DR severity per modified Davis staging — 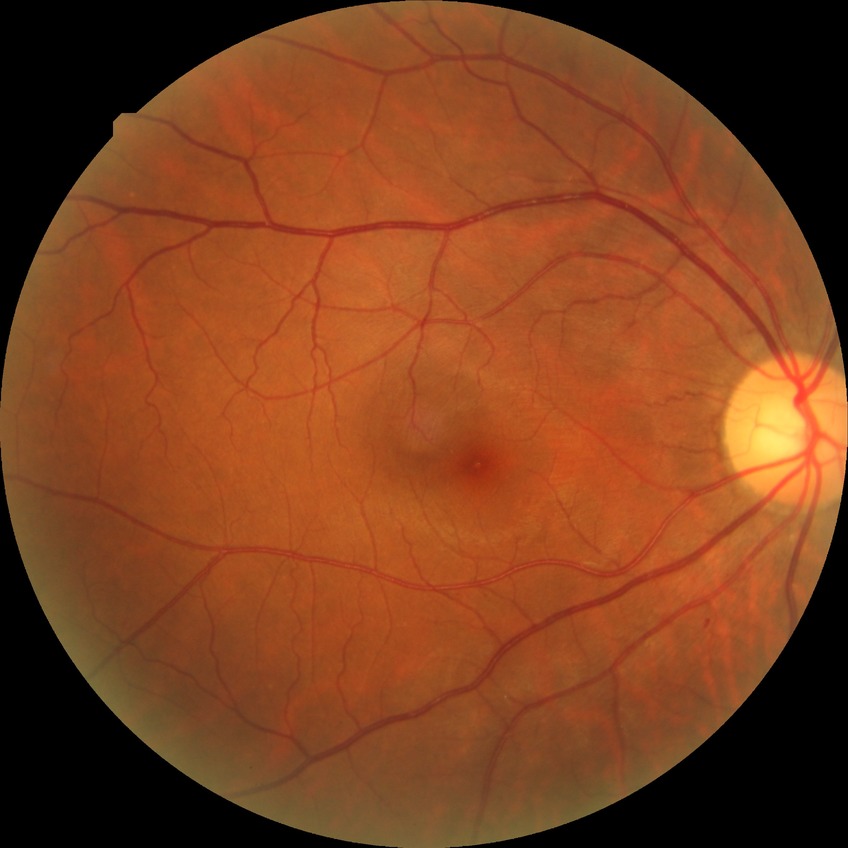
Annotations:
- DR class: non-proliferative diabetic retinopathy
- diabetic retinopathy stage: simple diabetic retinopathy